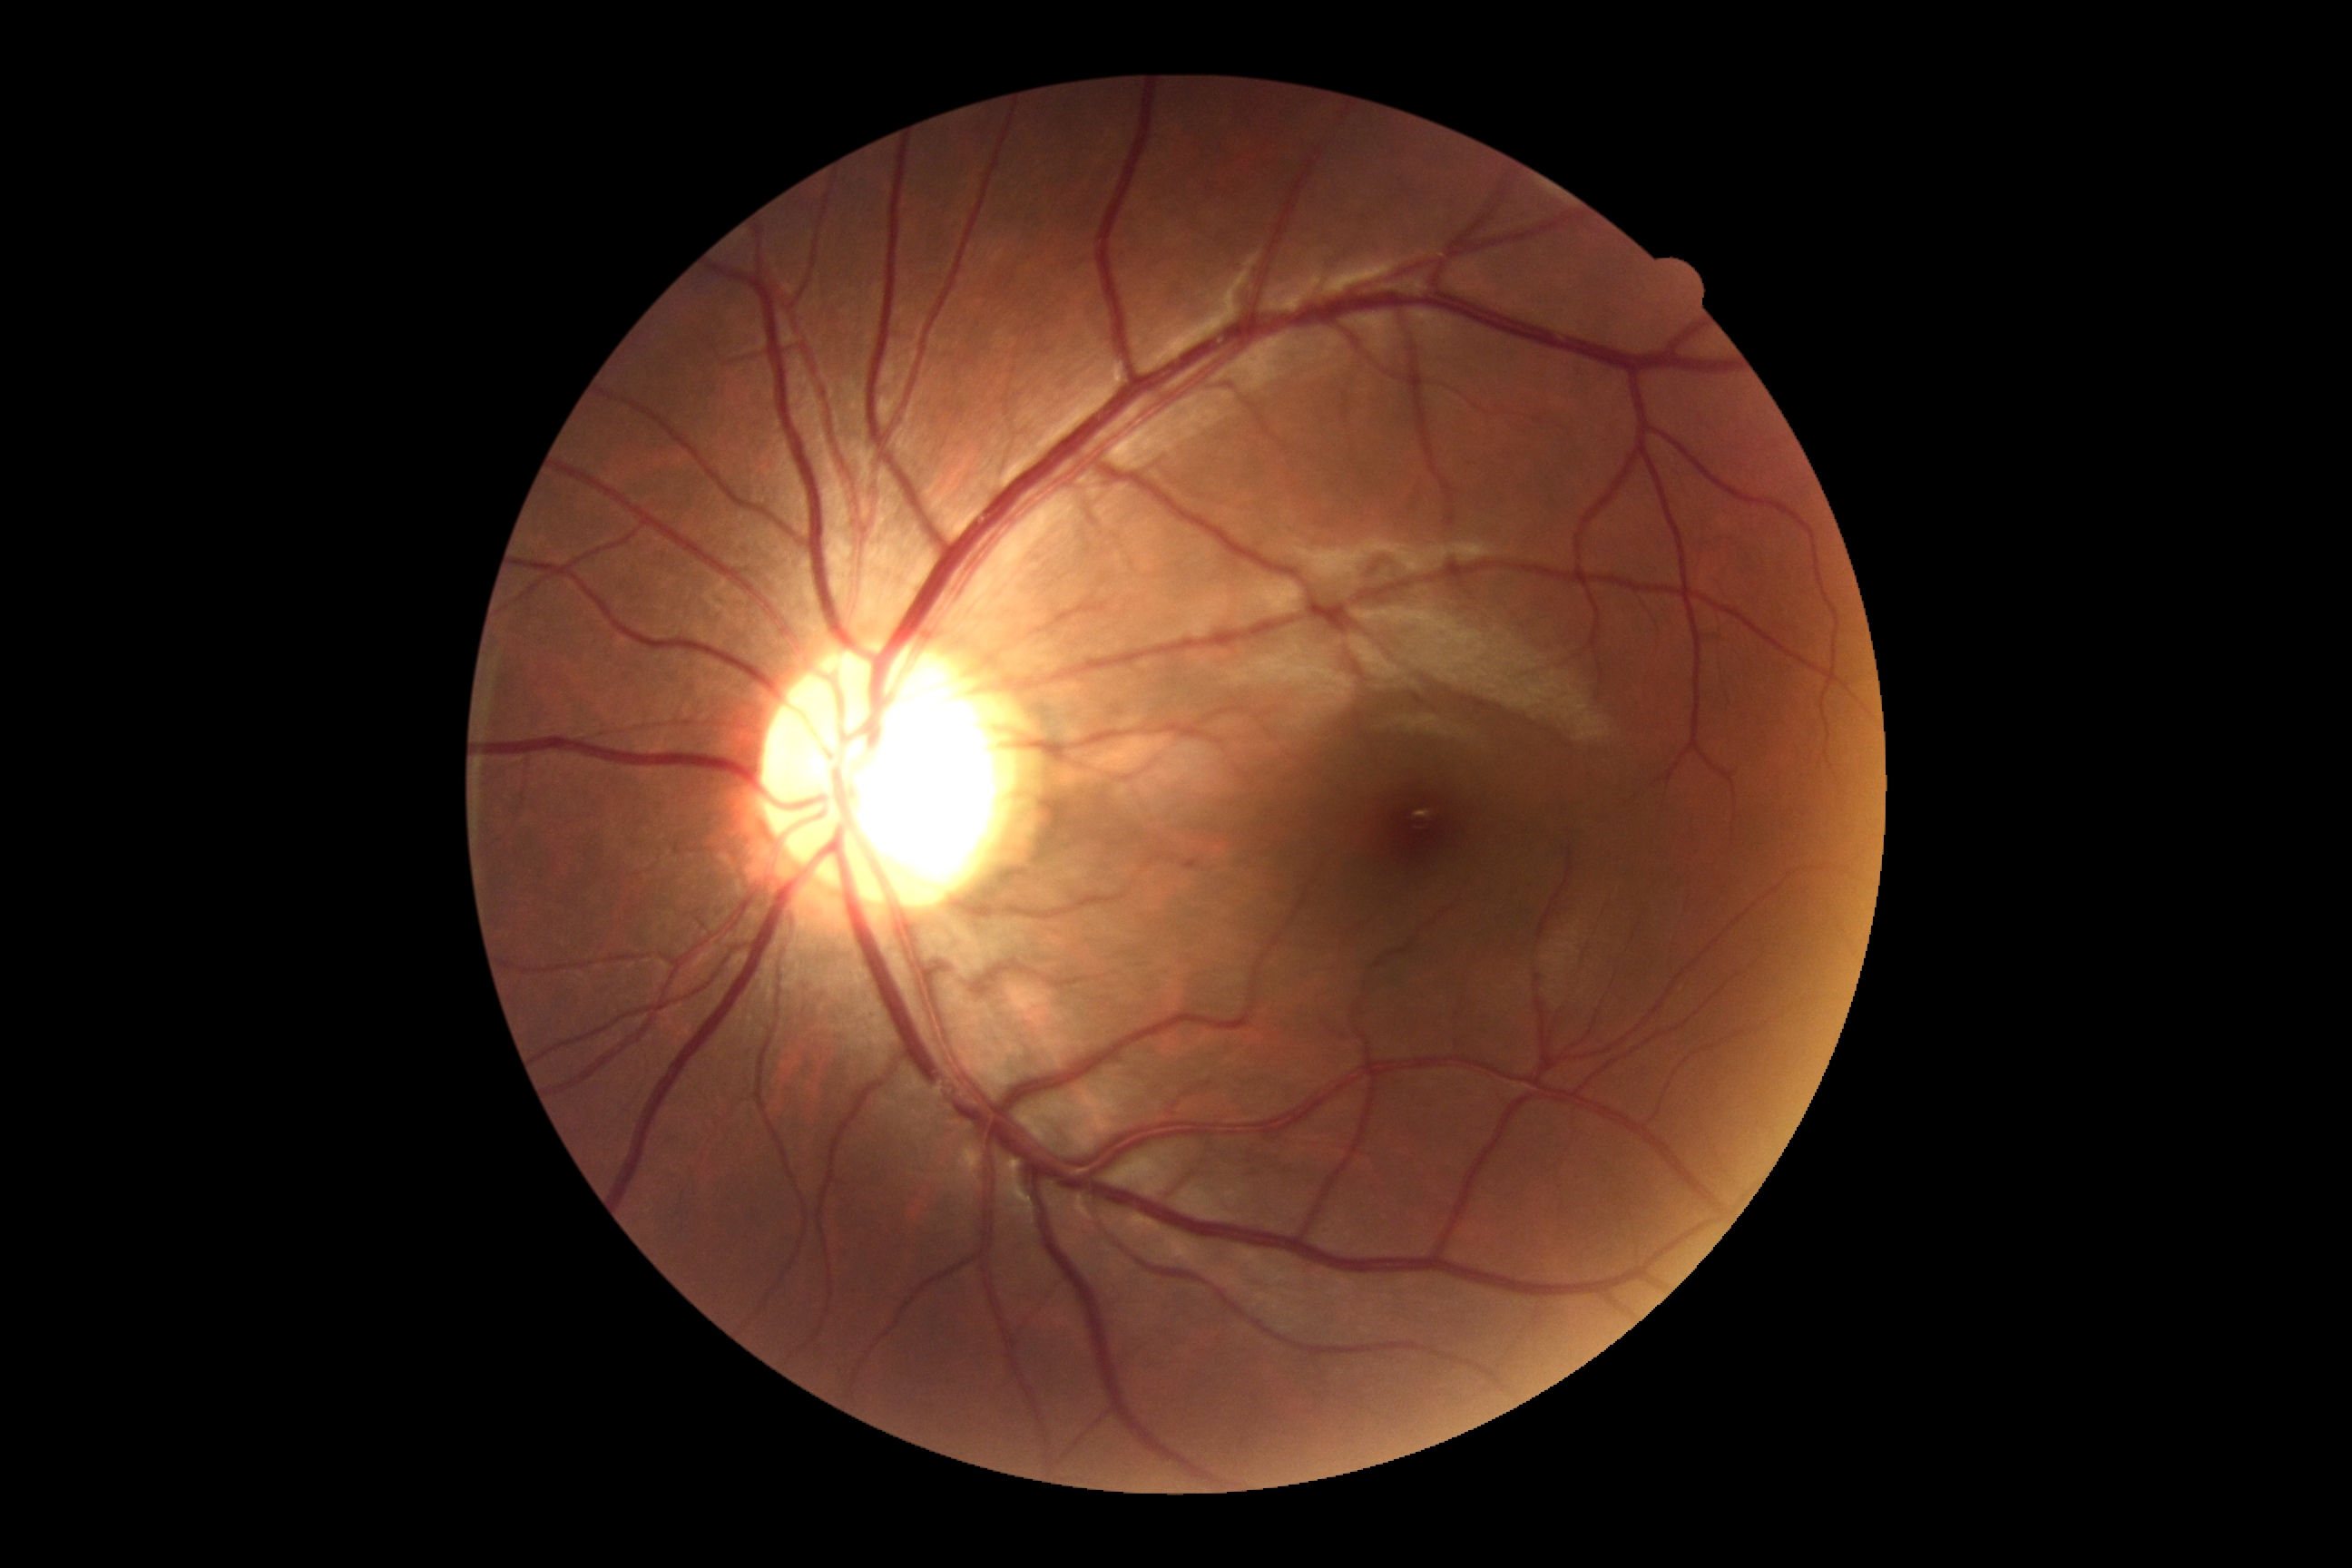
DR impression = no DR findings
retinopathy grade = 0/4